Phoenix ICON, 100° FOV; 1240 x 1240 pixels; infant wide-field retinal image: 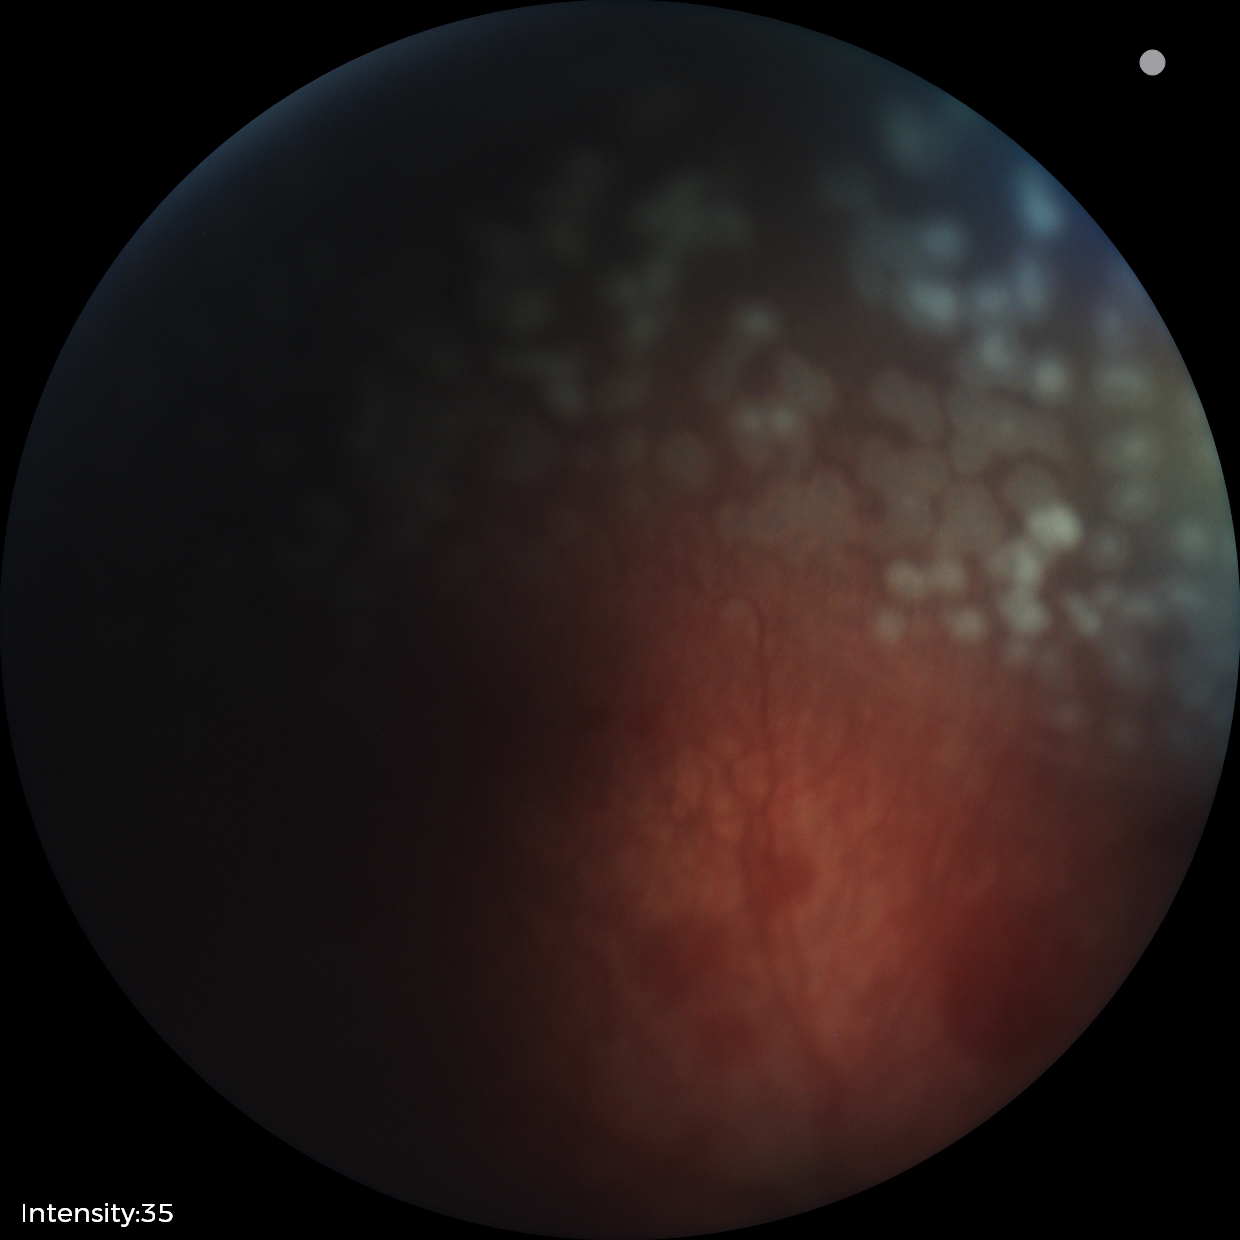
Q: What was the screening finding?
A: ROP stage 2
Q: What is the plus-form classification?
A: plus disease